Phoenix ICON wide-field infant fundus image. 100° field of view (Phoenix ICON): 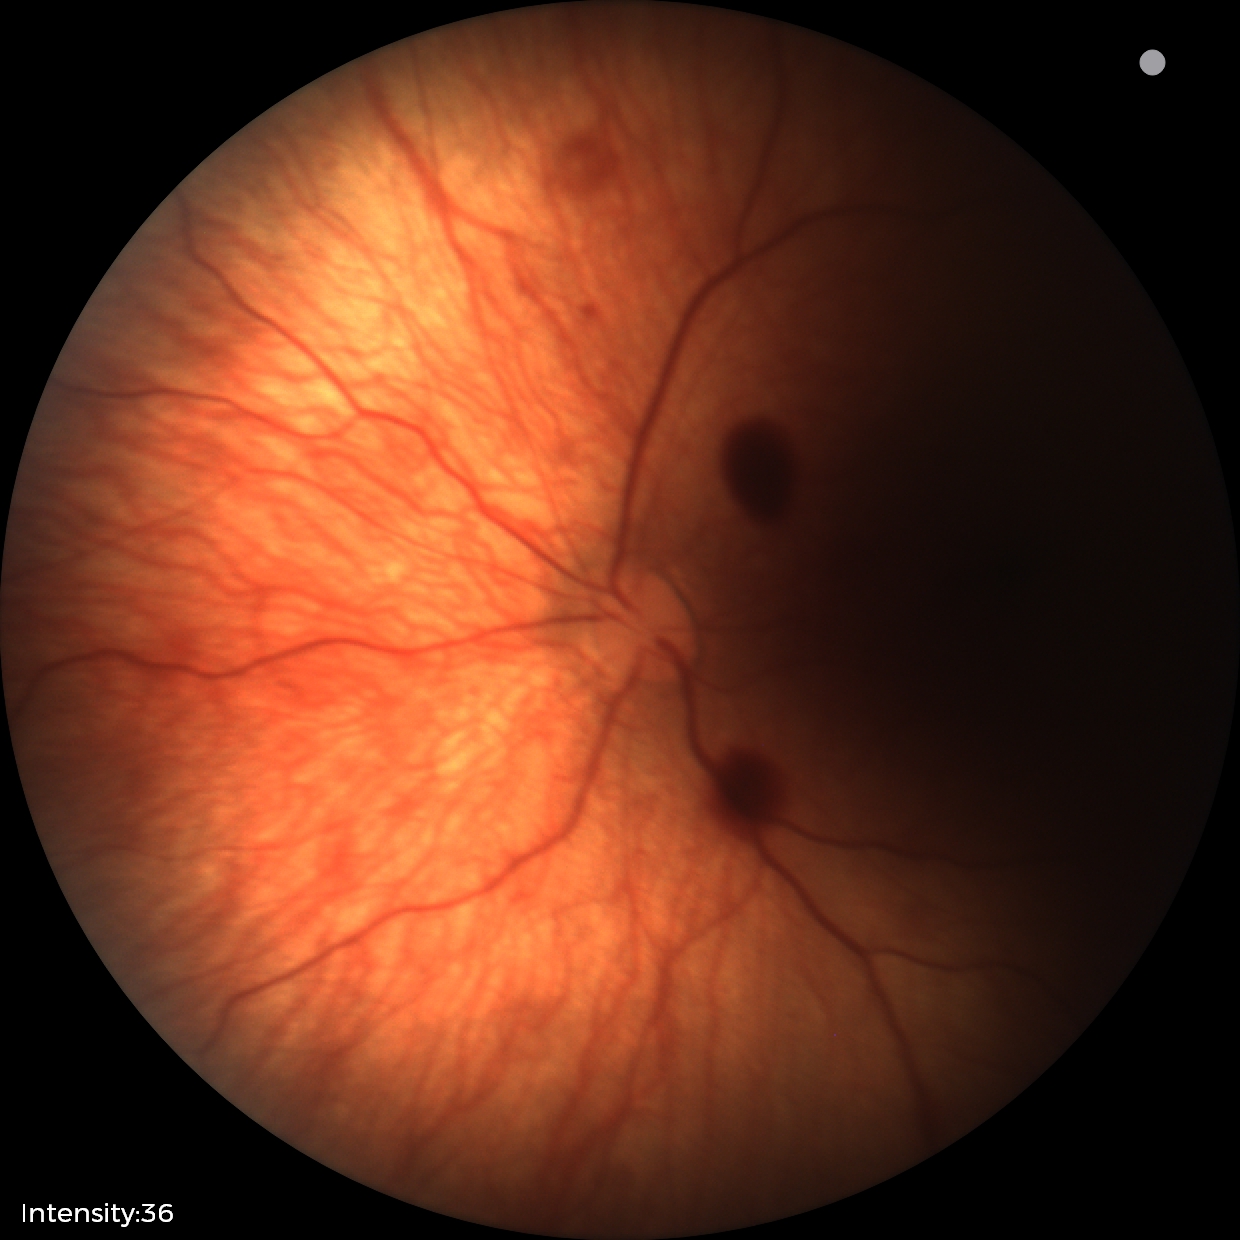 Q: What is the screening diagnosis?
A: retinal hemorrhages